45-degree field of view.
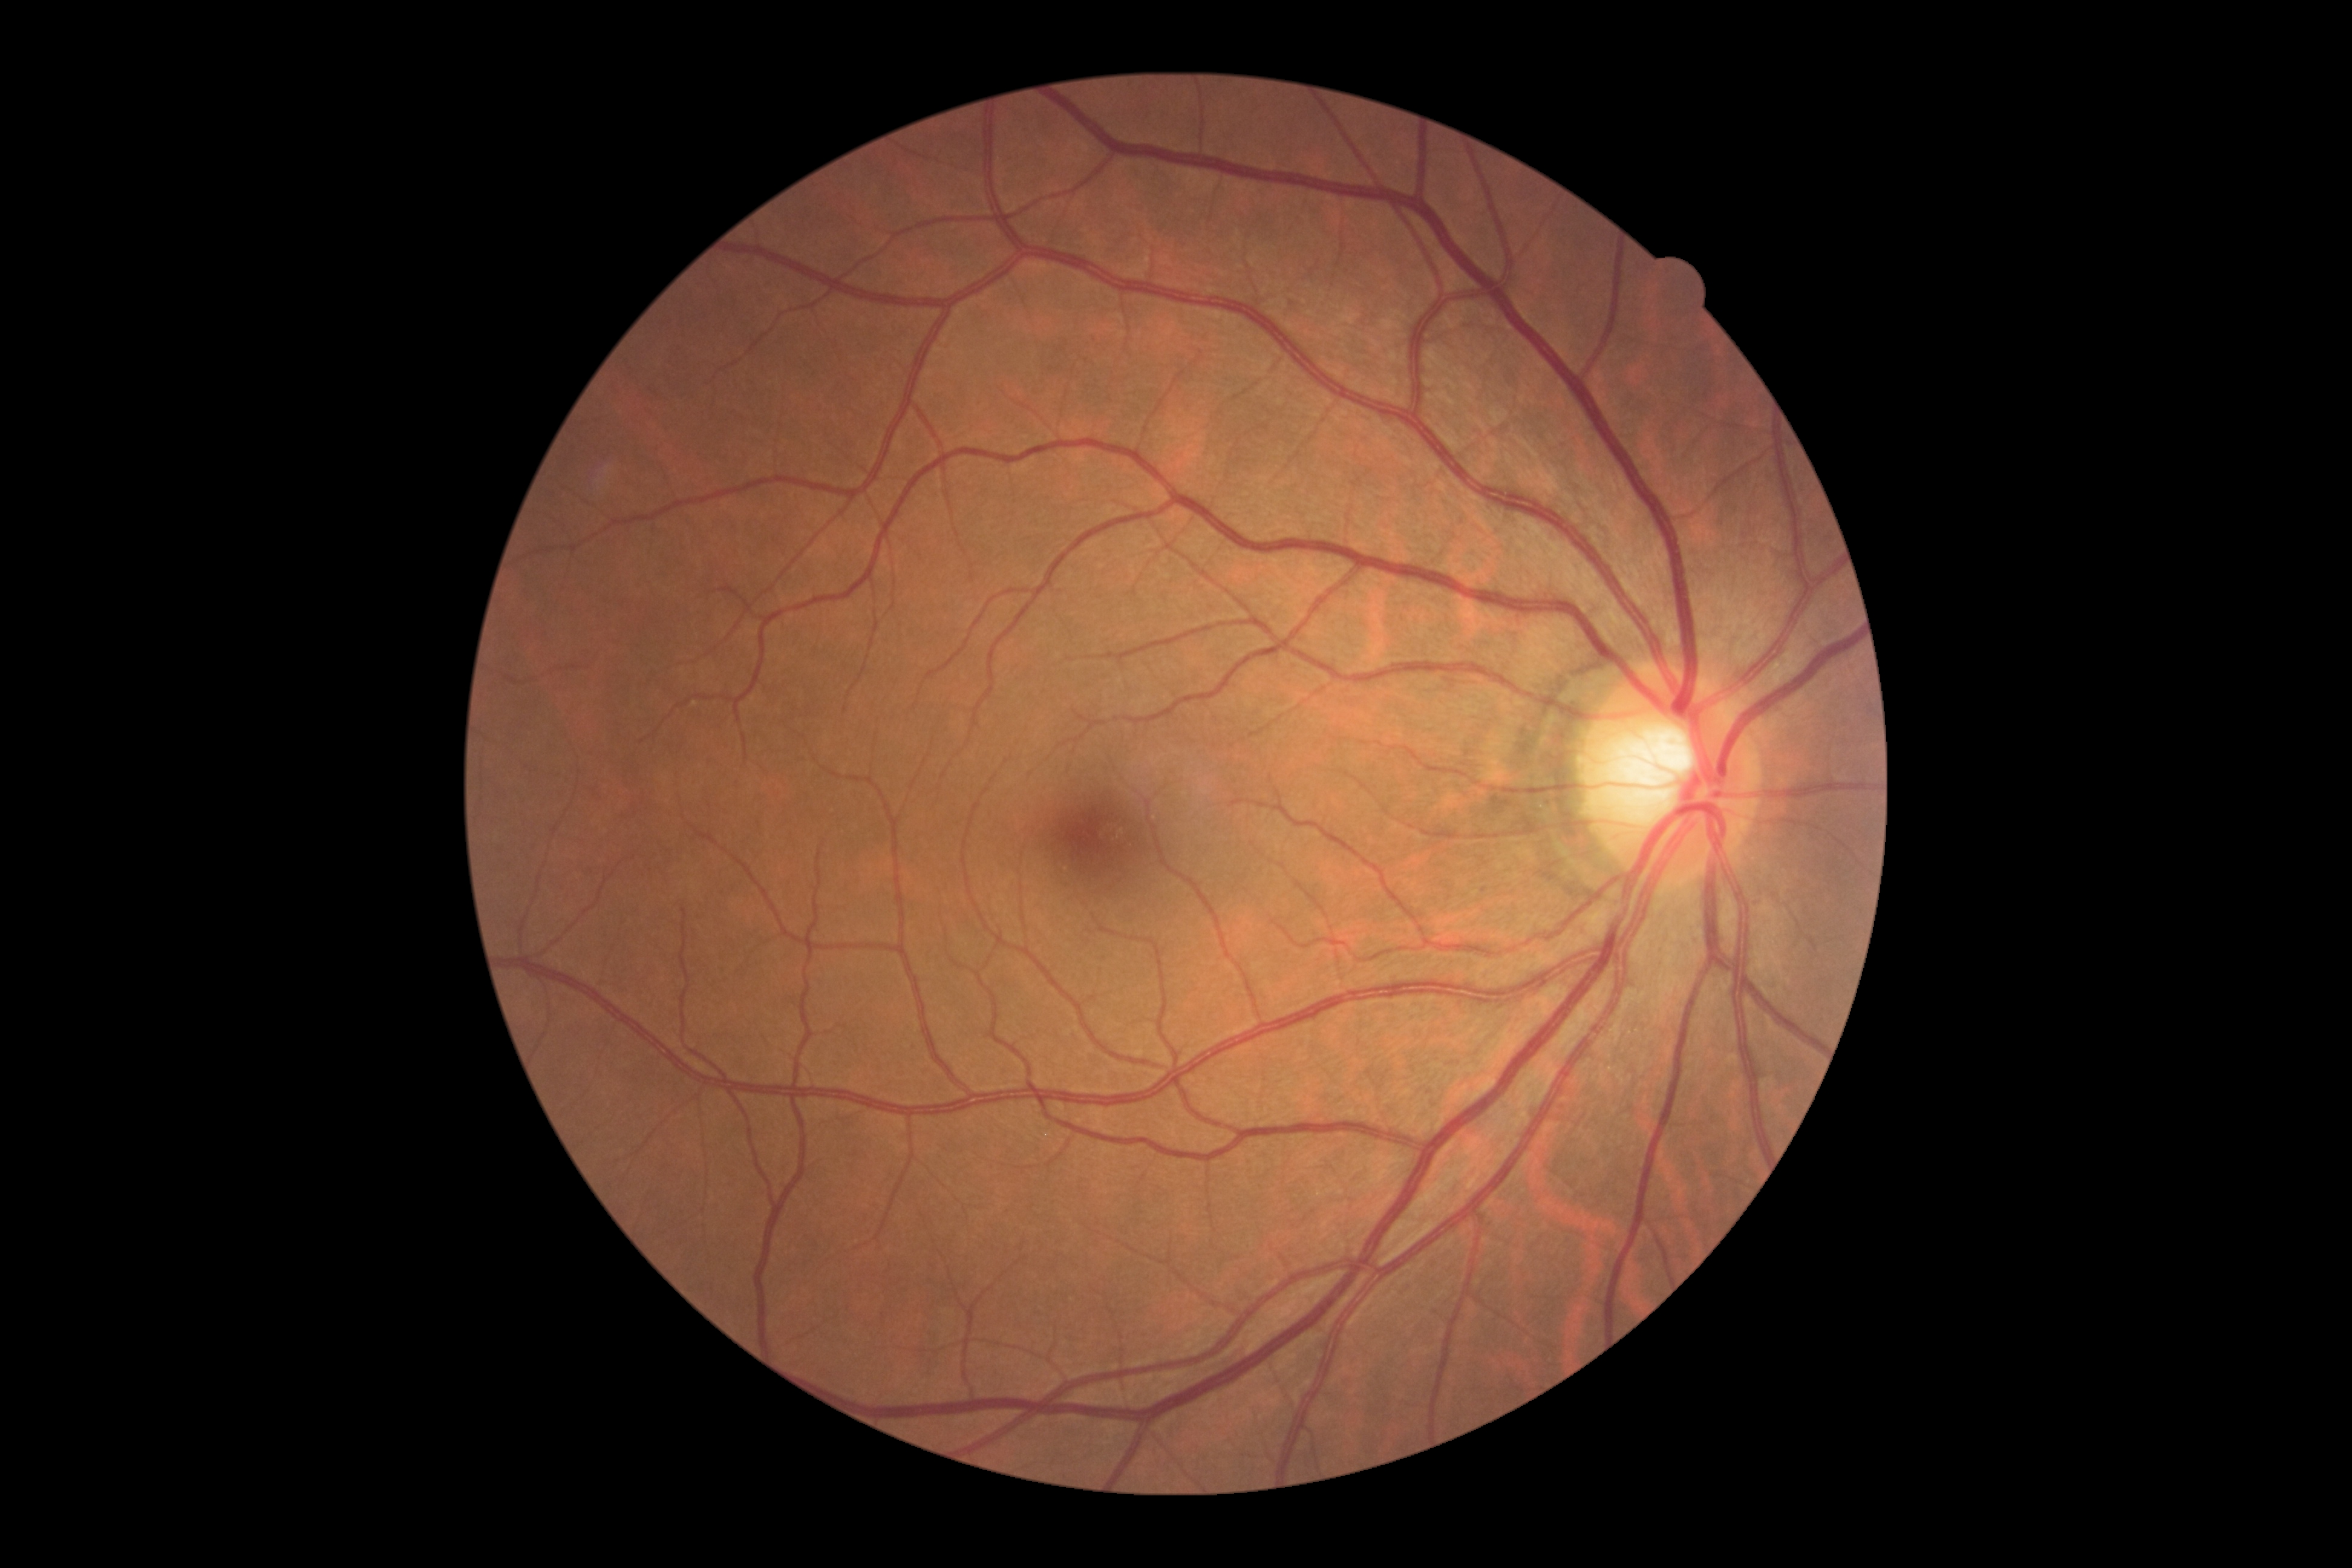

Diabetic retinopathy (DR): grade 0. No diabetic retinal disease findings.